Fundus photo; 1536 by 1152 pixels.
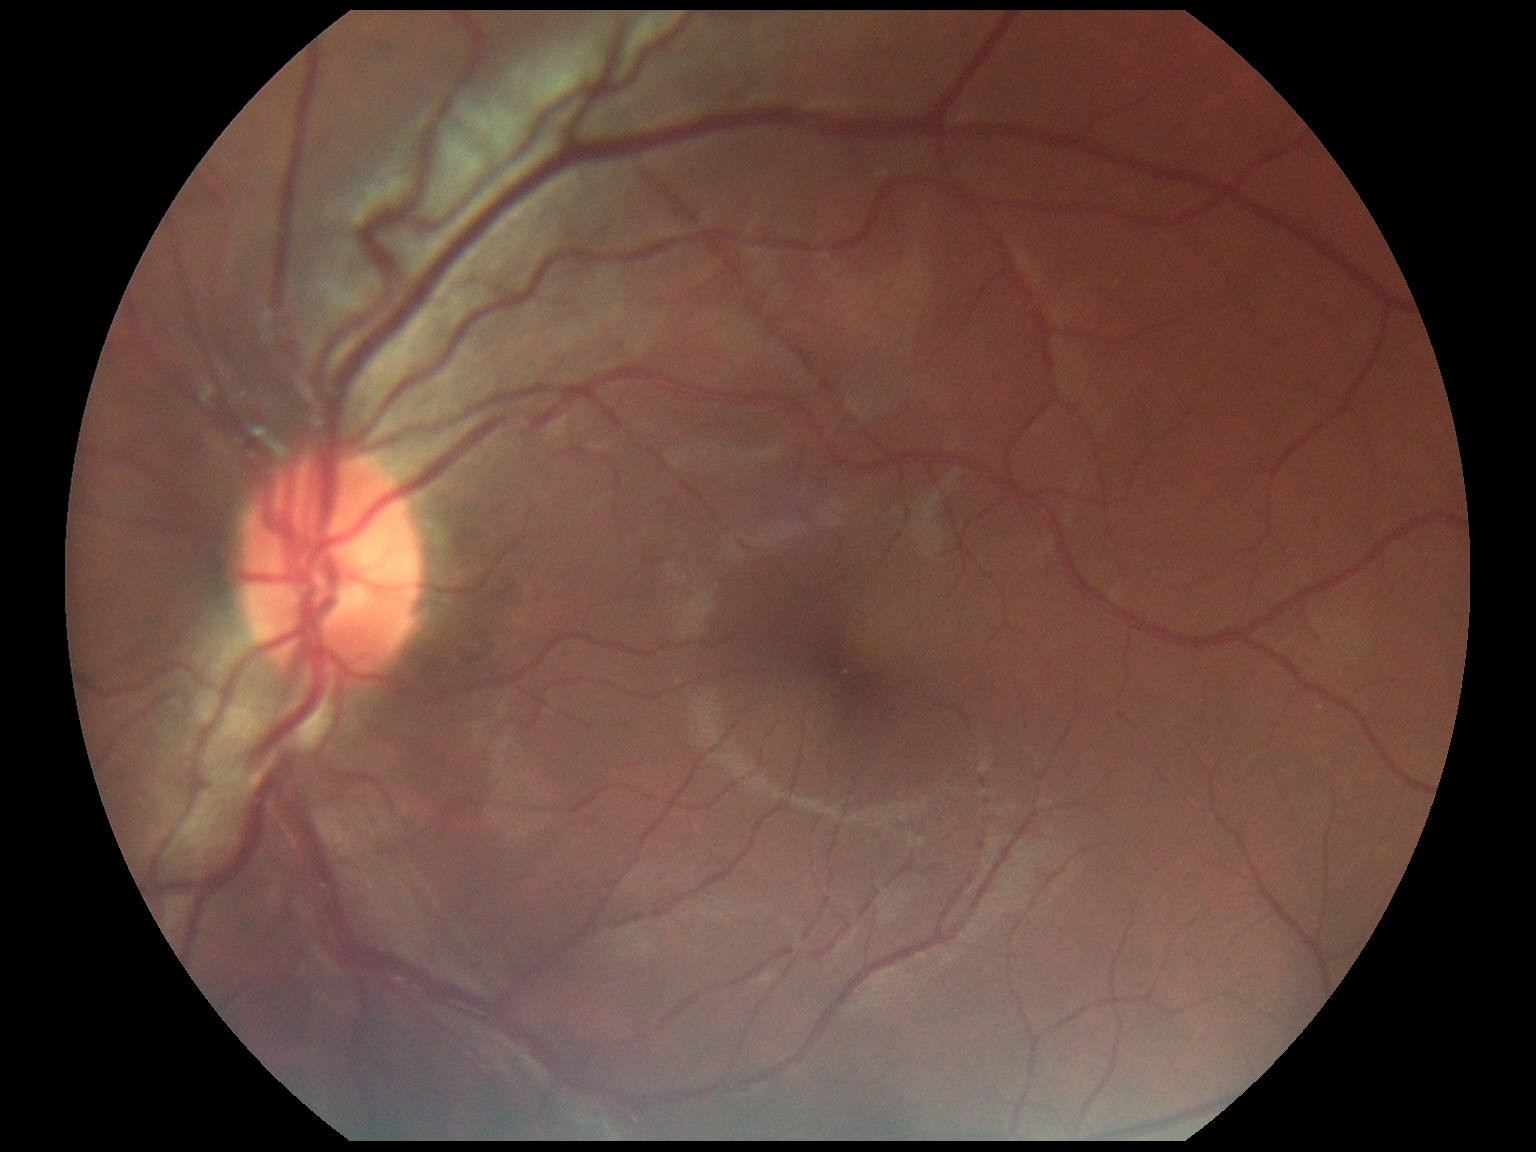
DR severity: 0/4.